2212 x 1659 pixels · CFP · FOV: 45 degrees
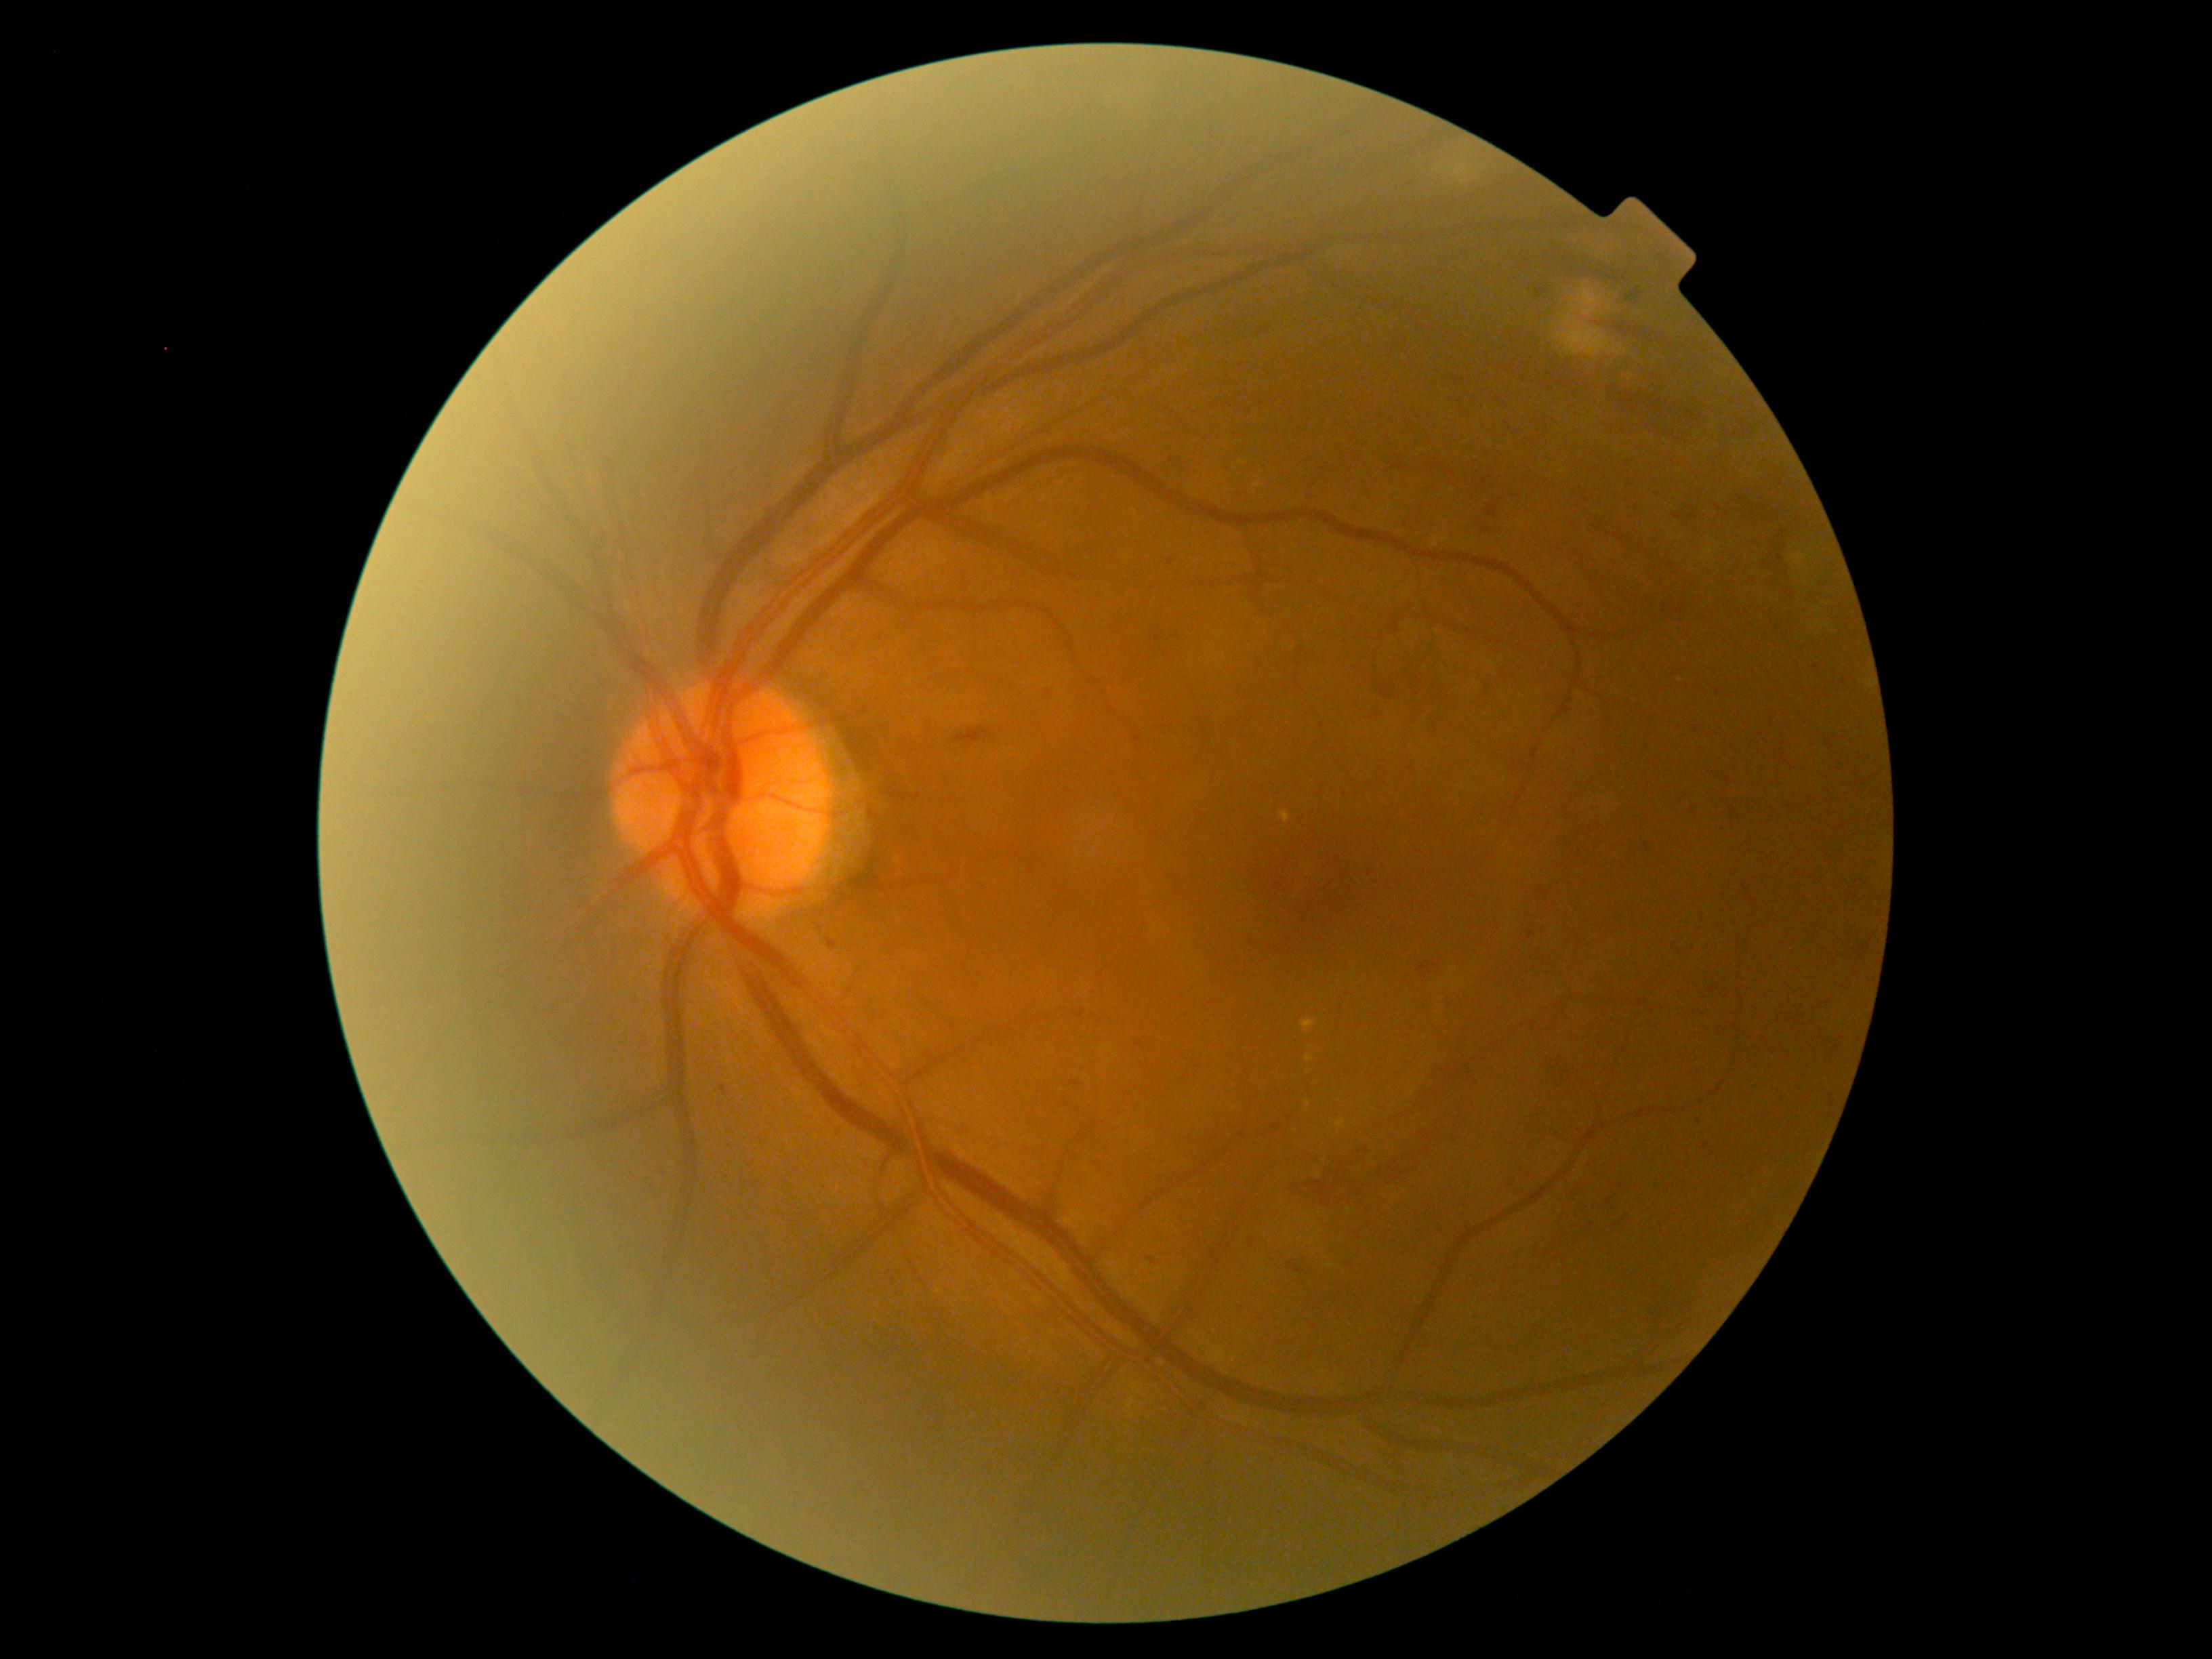 {
  "dr_category": "non-proliferative diabetic retinopathy",
  "dr_grade": "grade 2"
}